Acquired with a NIDEK AFC-230; modified Davis grading
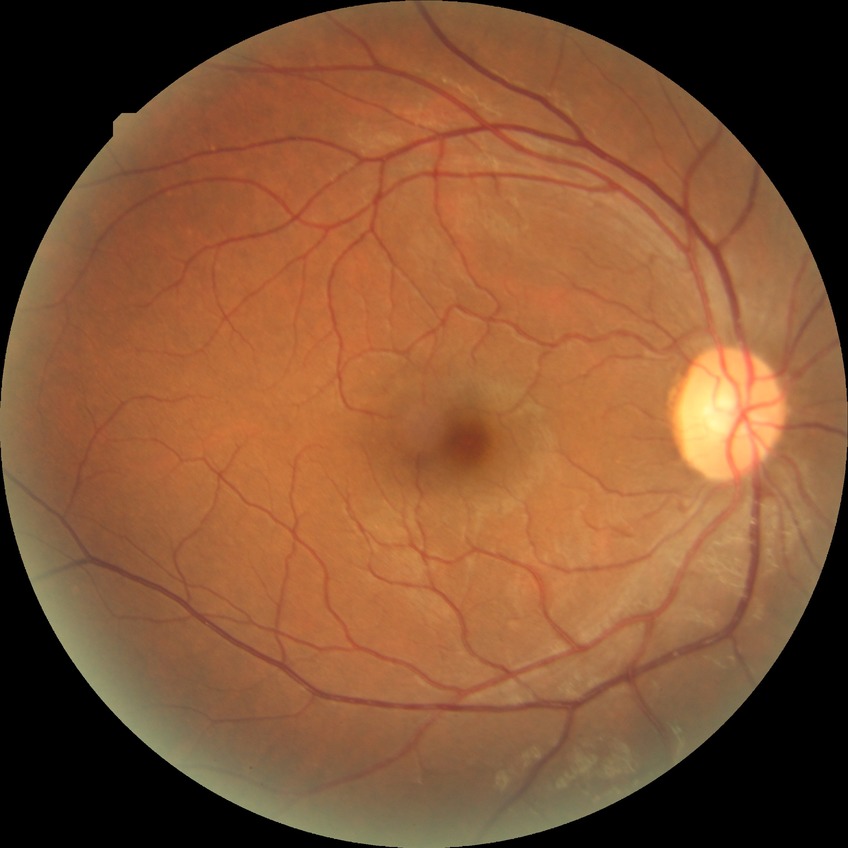 Diabetic retinopathy severity: no diabetic retinopathy.